848 by 848 pixels, color fundus photograph — 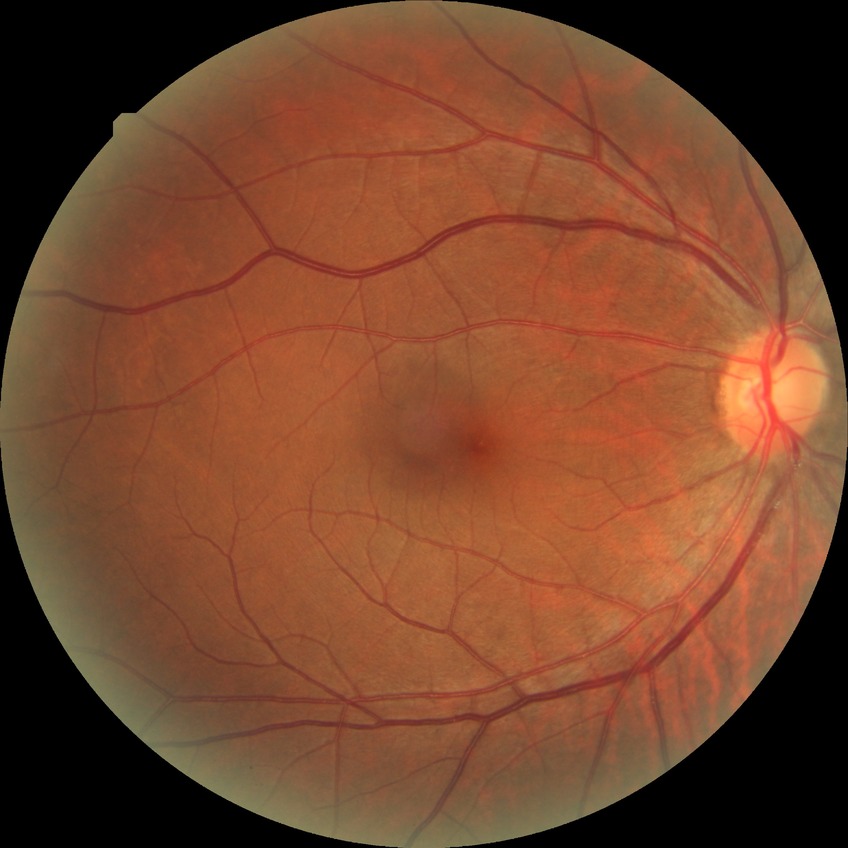

Diabetic retinopathy (DR): NDR (no diabetic retinopathy).